2048x1536; 45° field of view:
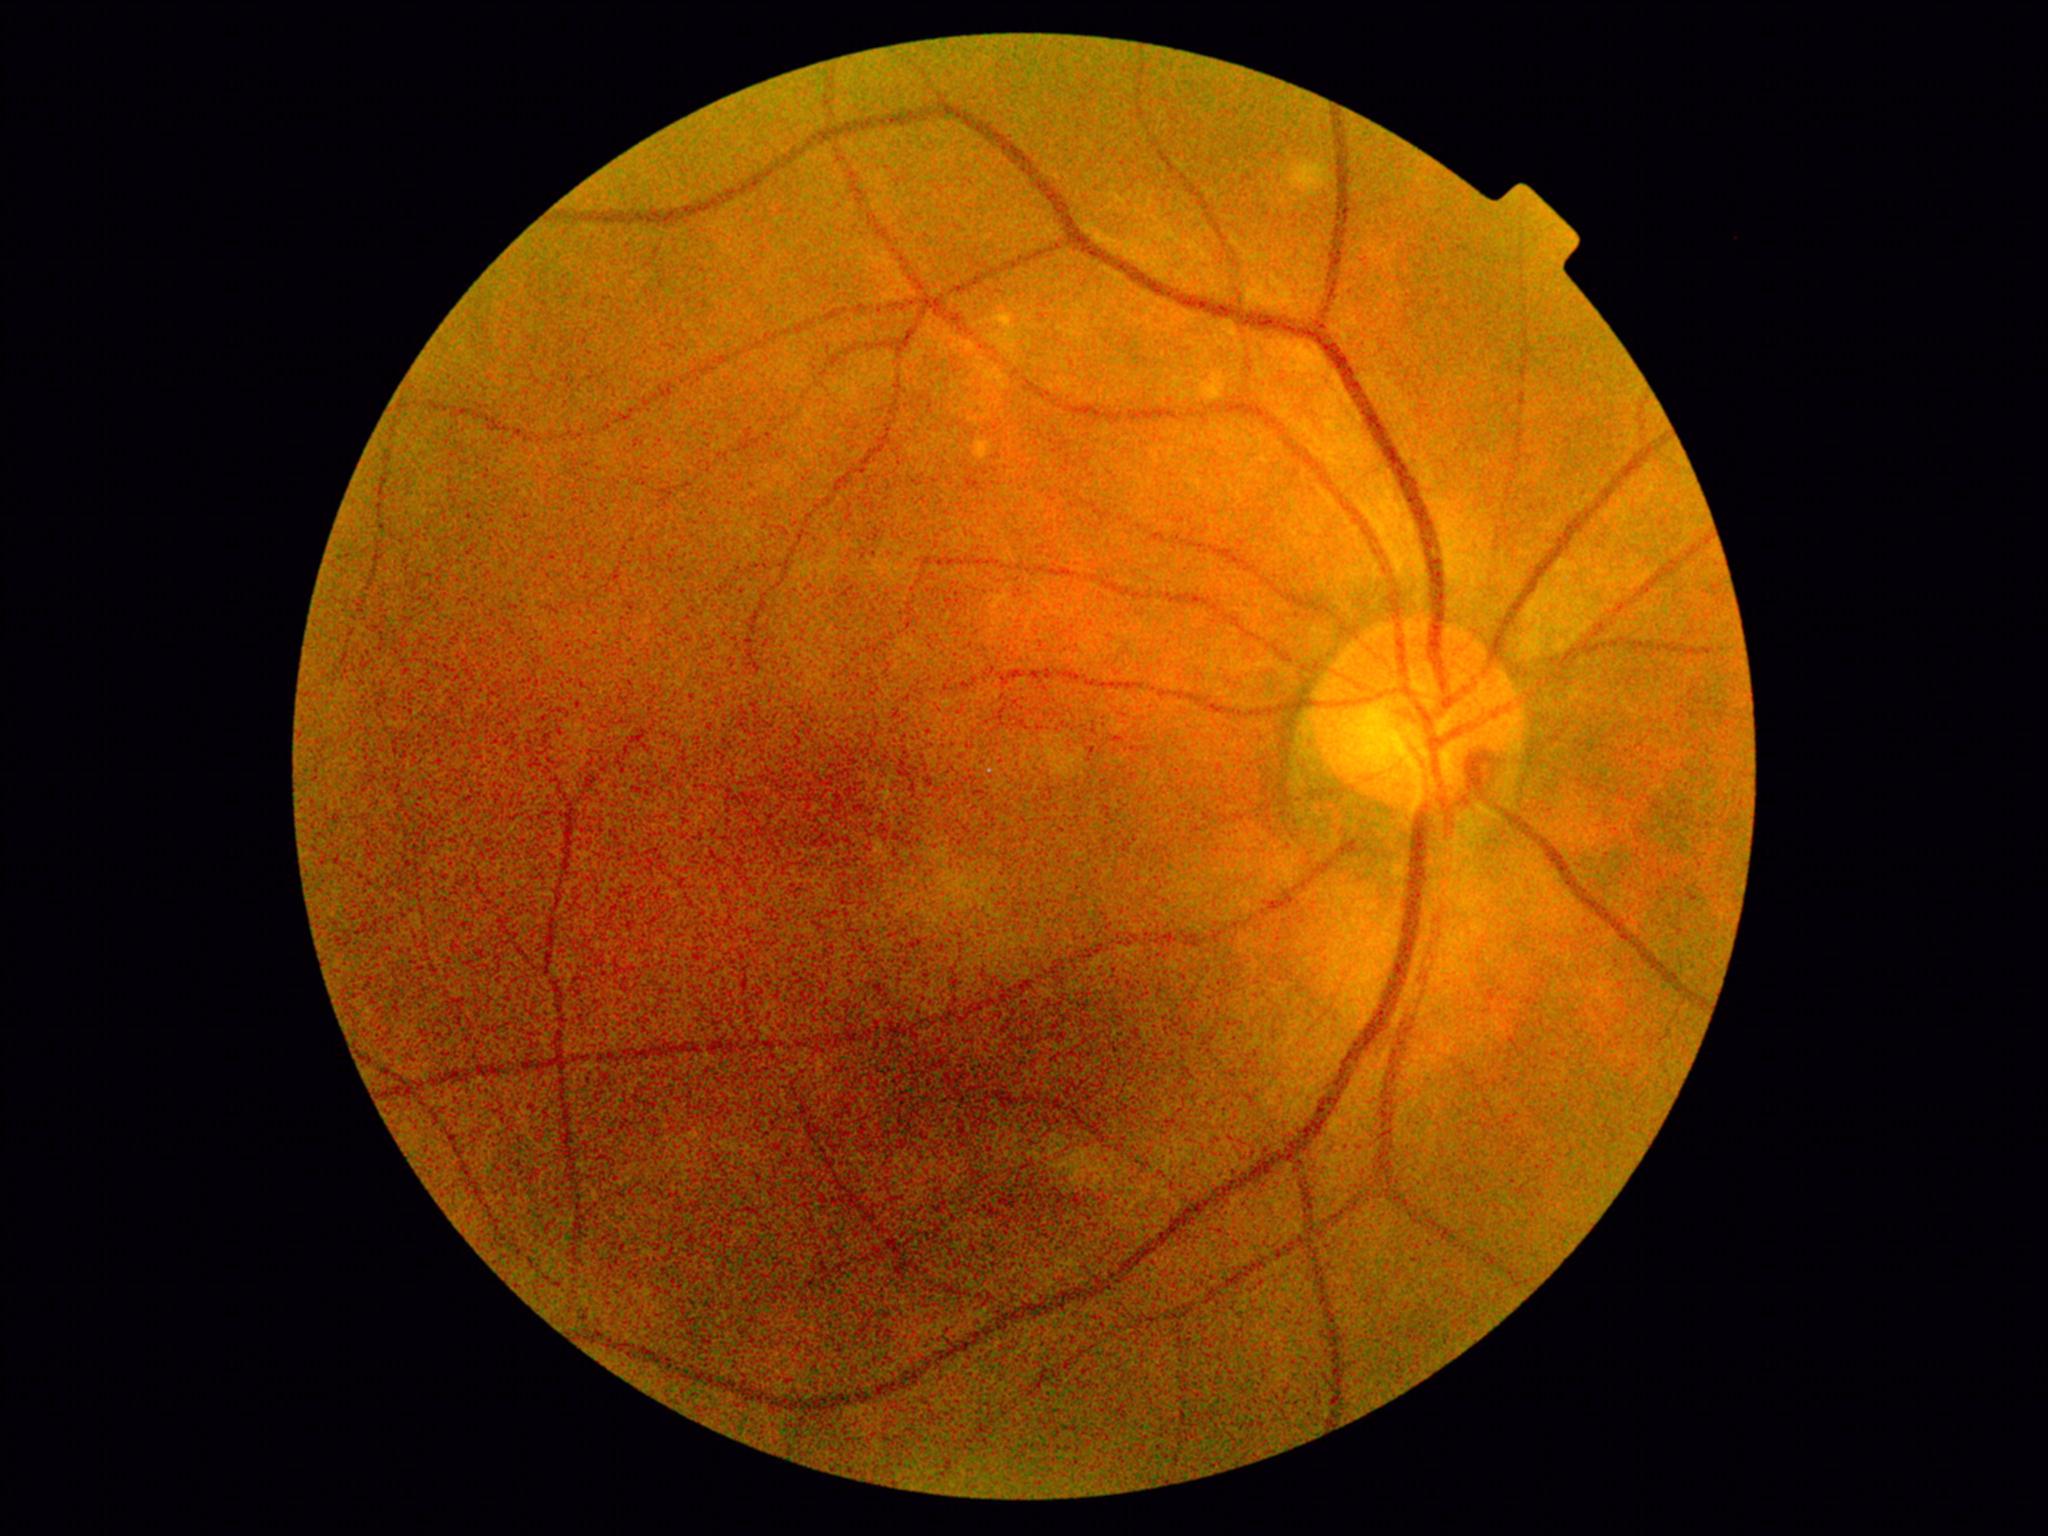 Diabetic retinopathy (DR) is no apparent diabetic retinopathy (grade 0).